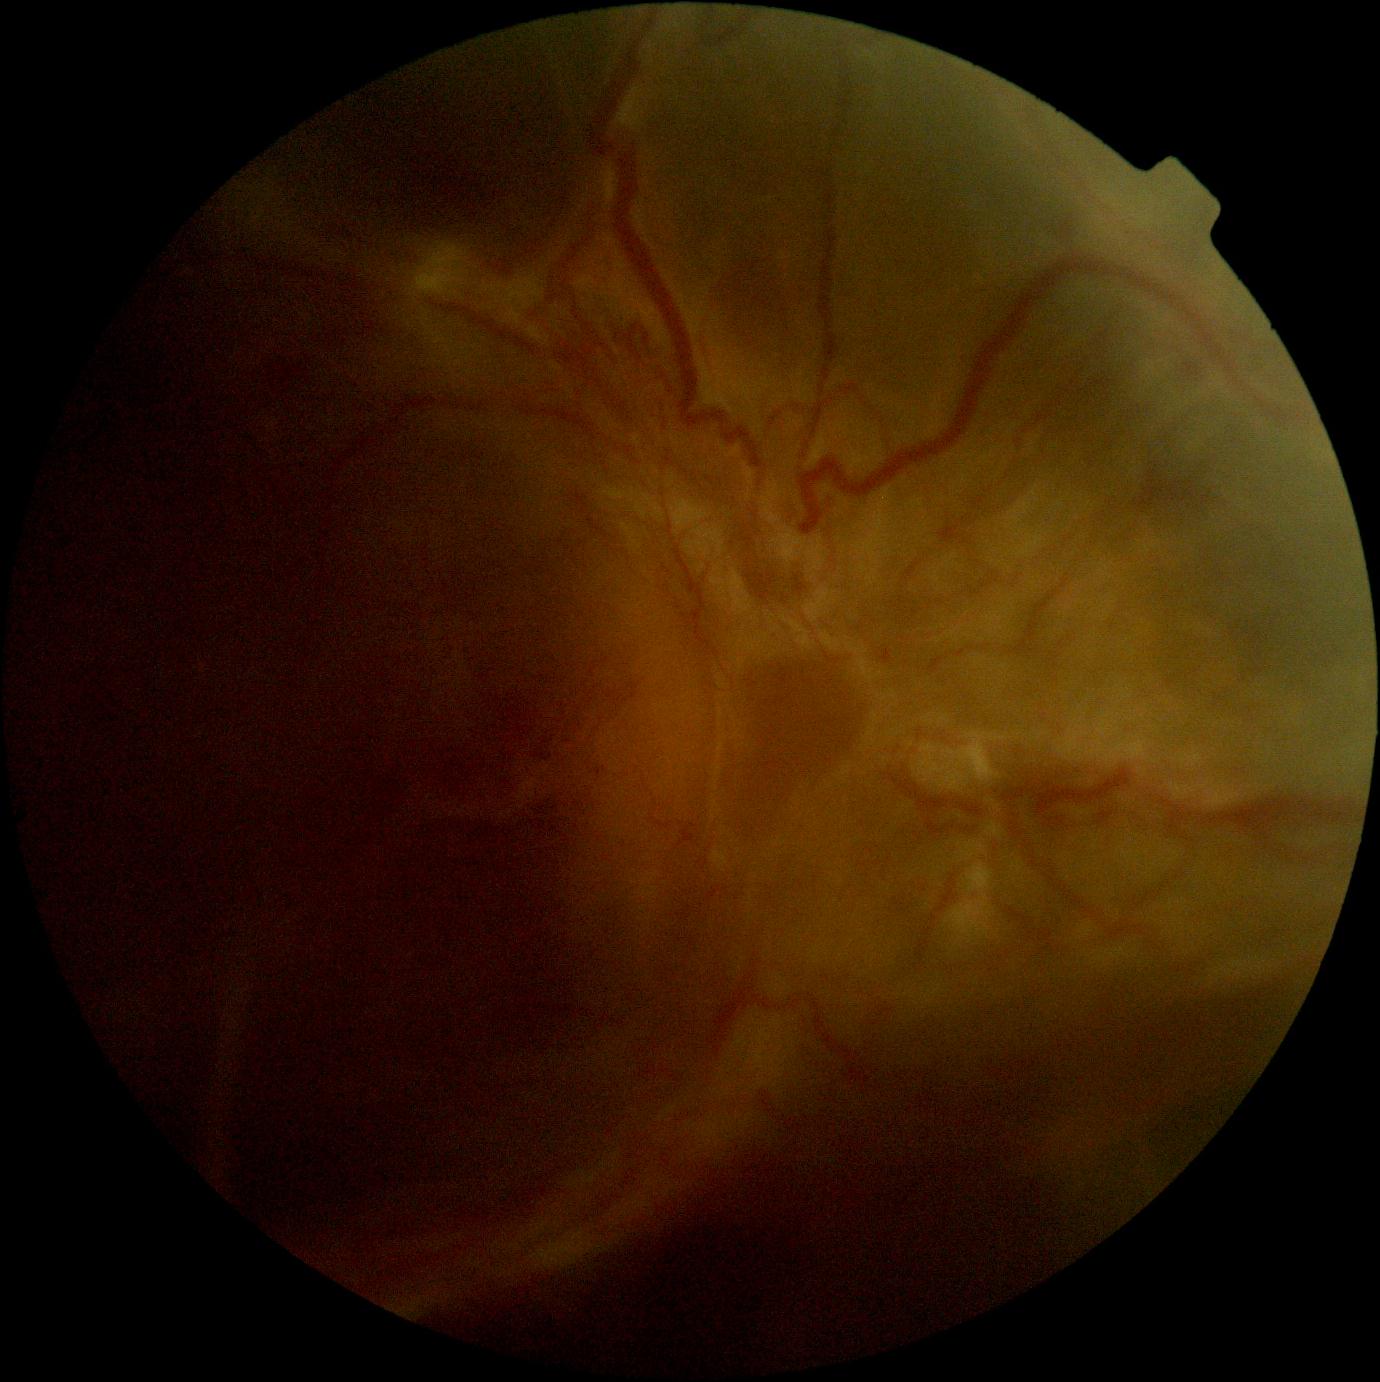 DR is grade 4 — neovascularization and/or vitreous/pre-retinal hemorrhage.